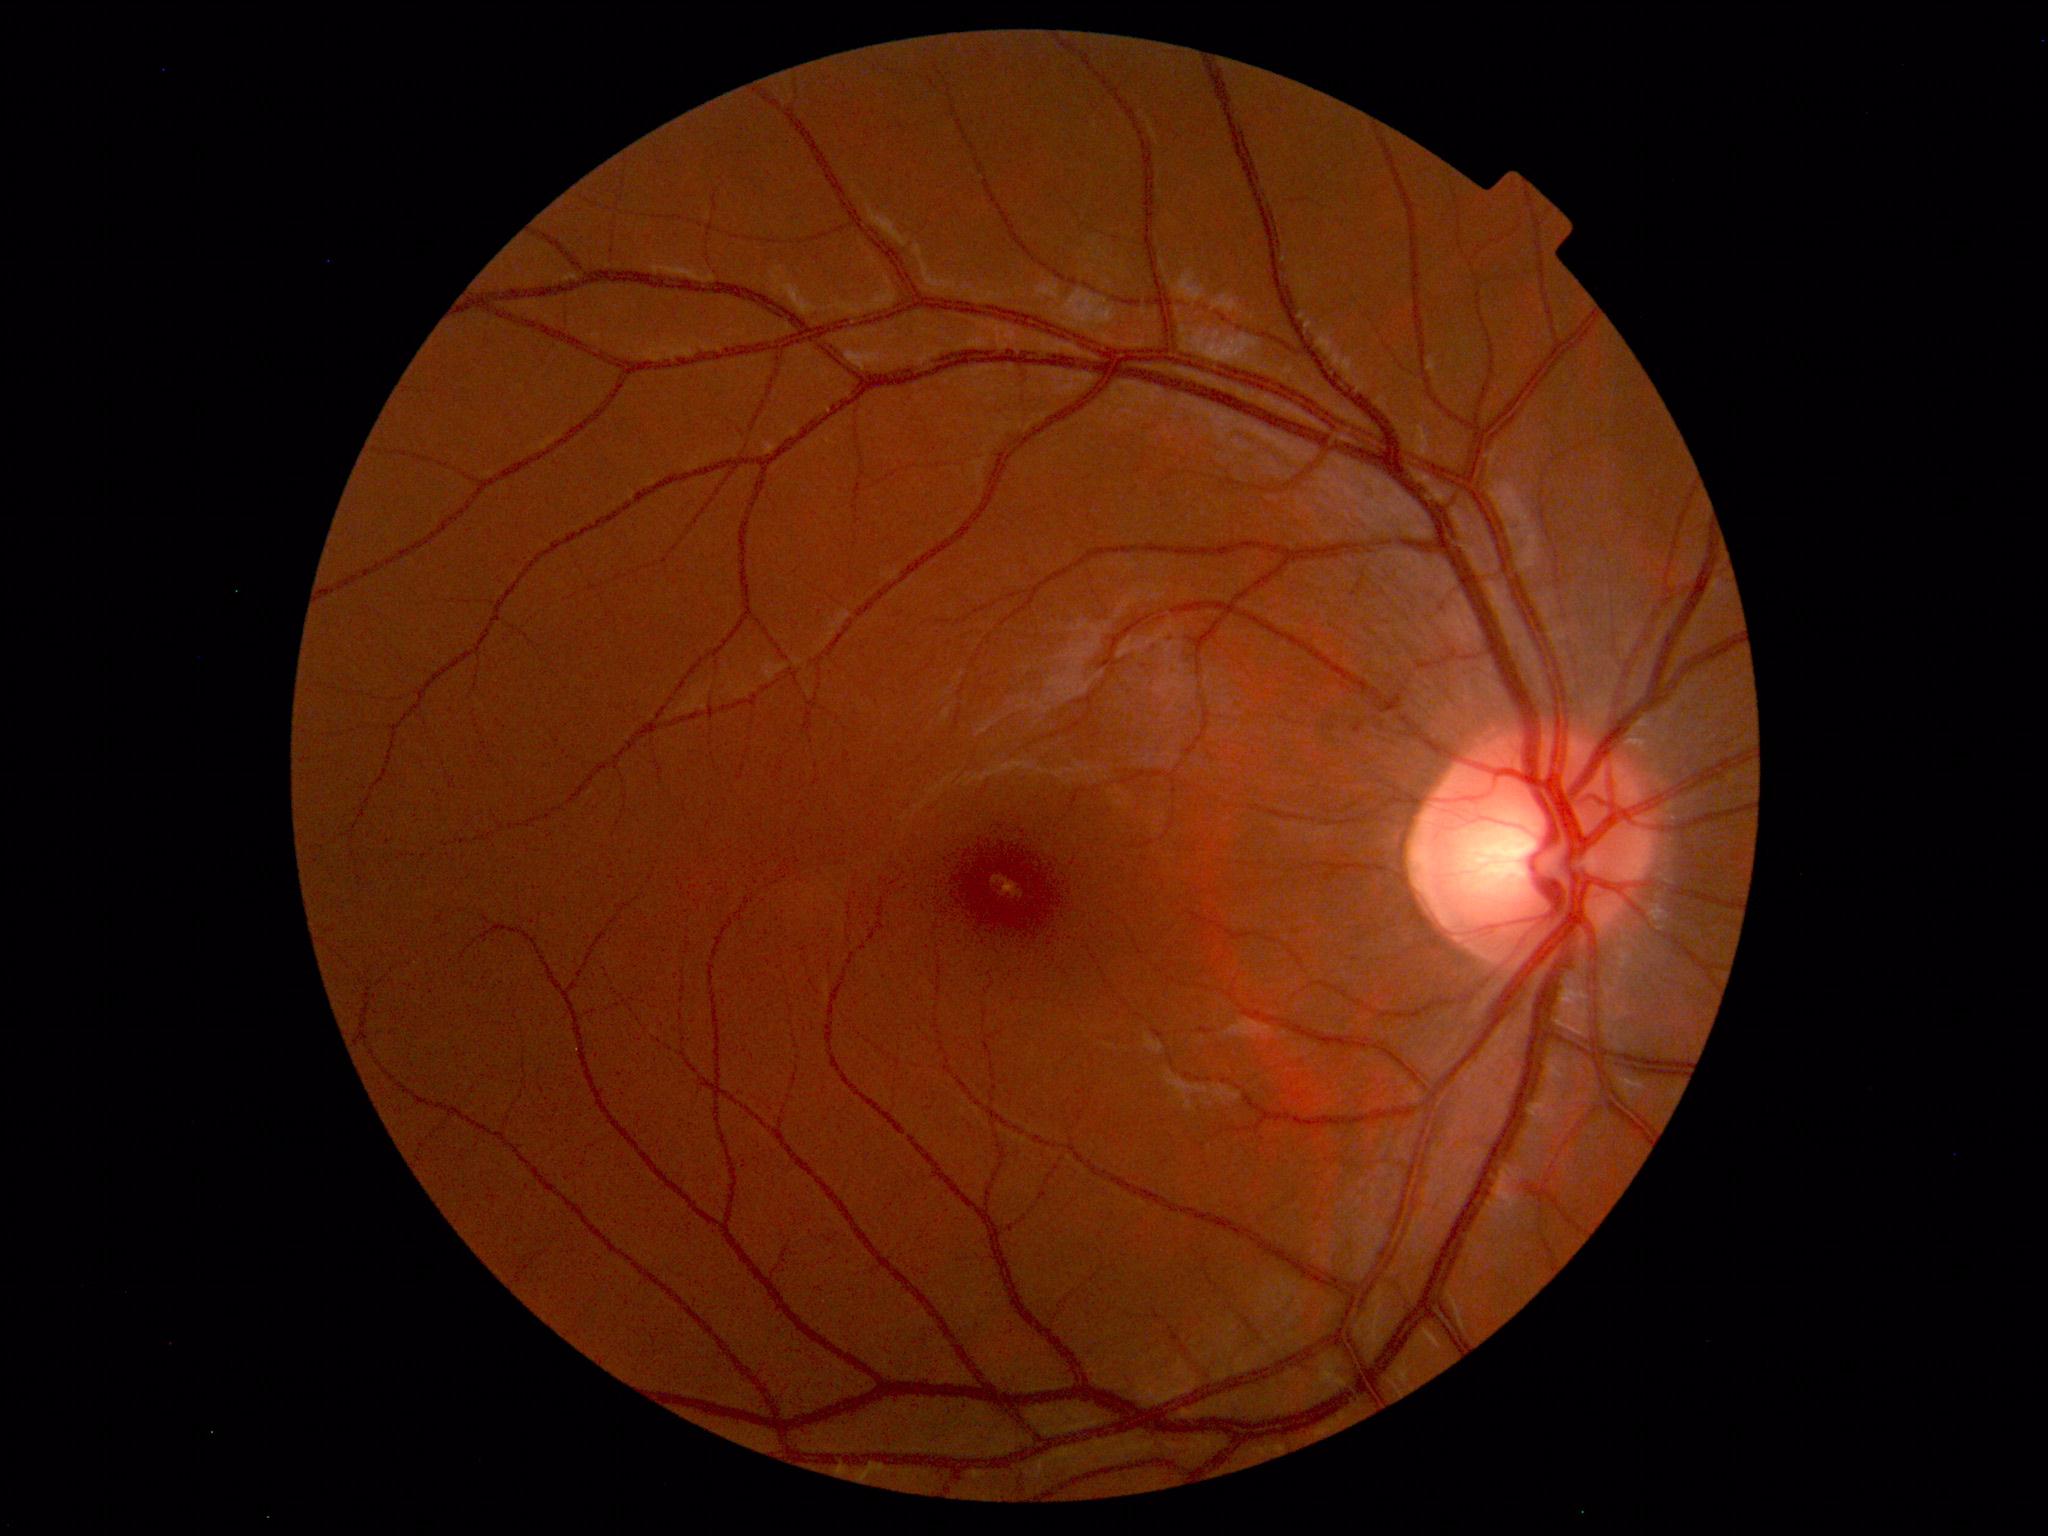
Findings: no abnormalities.